Image size 512x512: 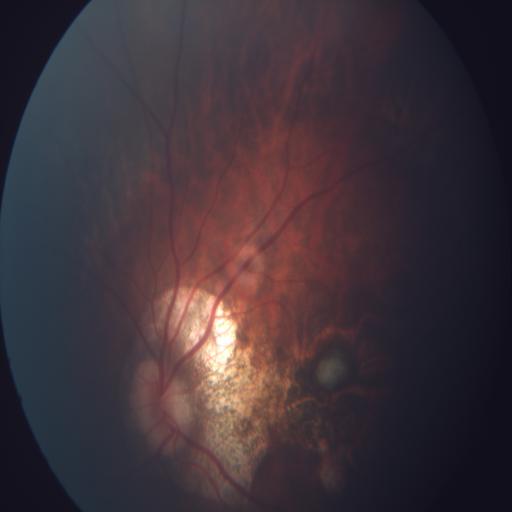 Diagnosis:
- myopia (MYA)
- tessellation (TSLN)